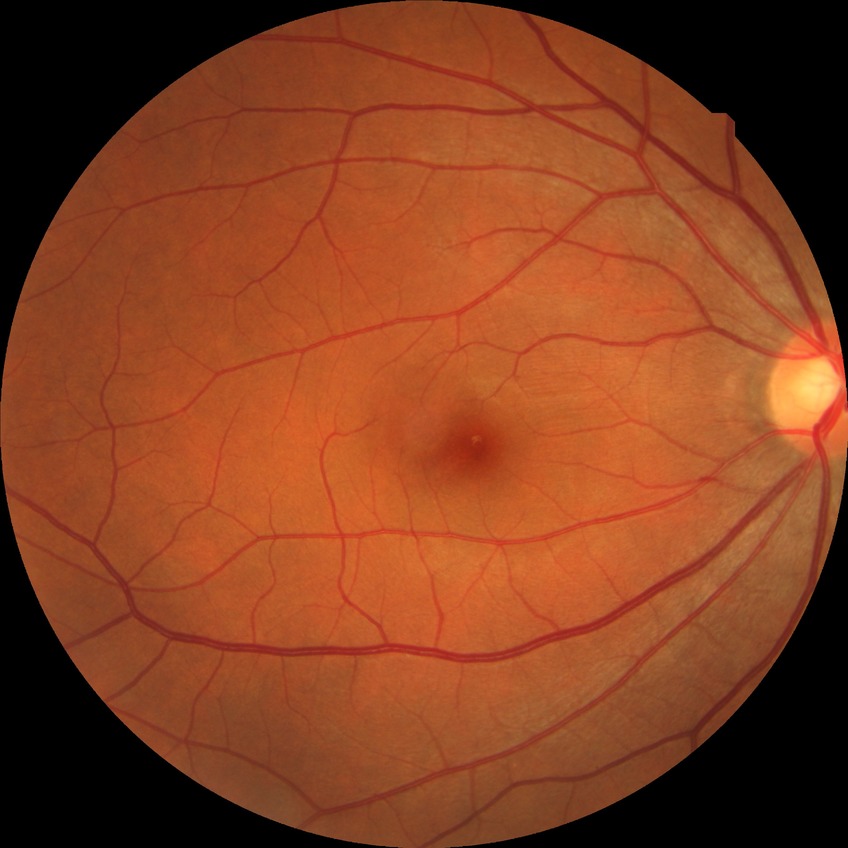 Davis stage: NDR.
No DR findings.